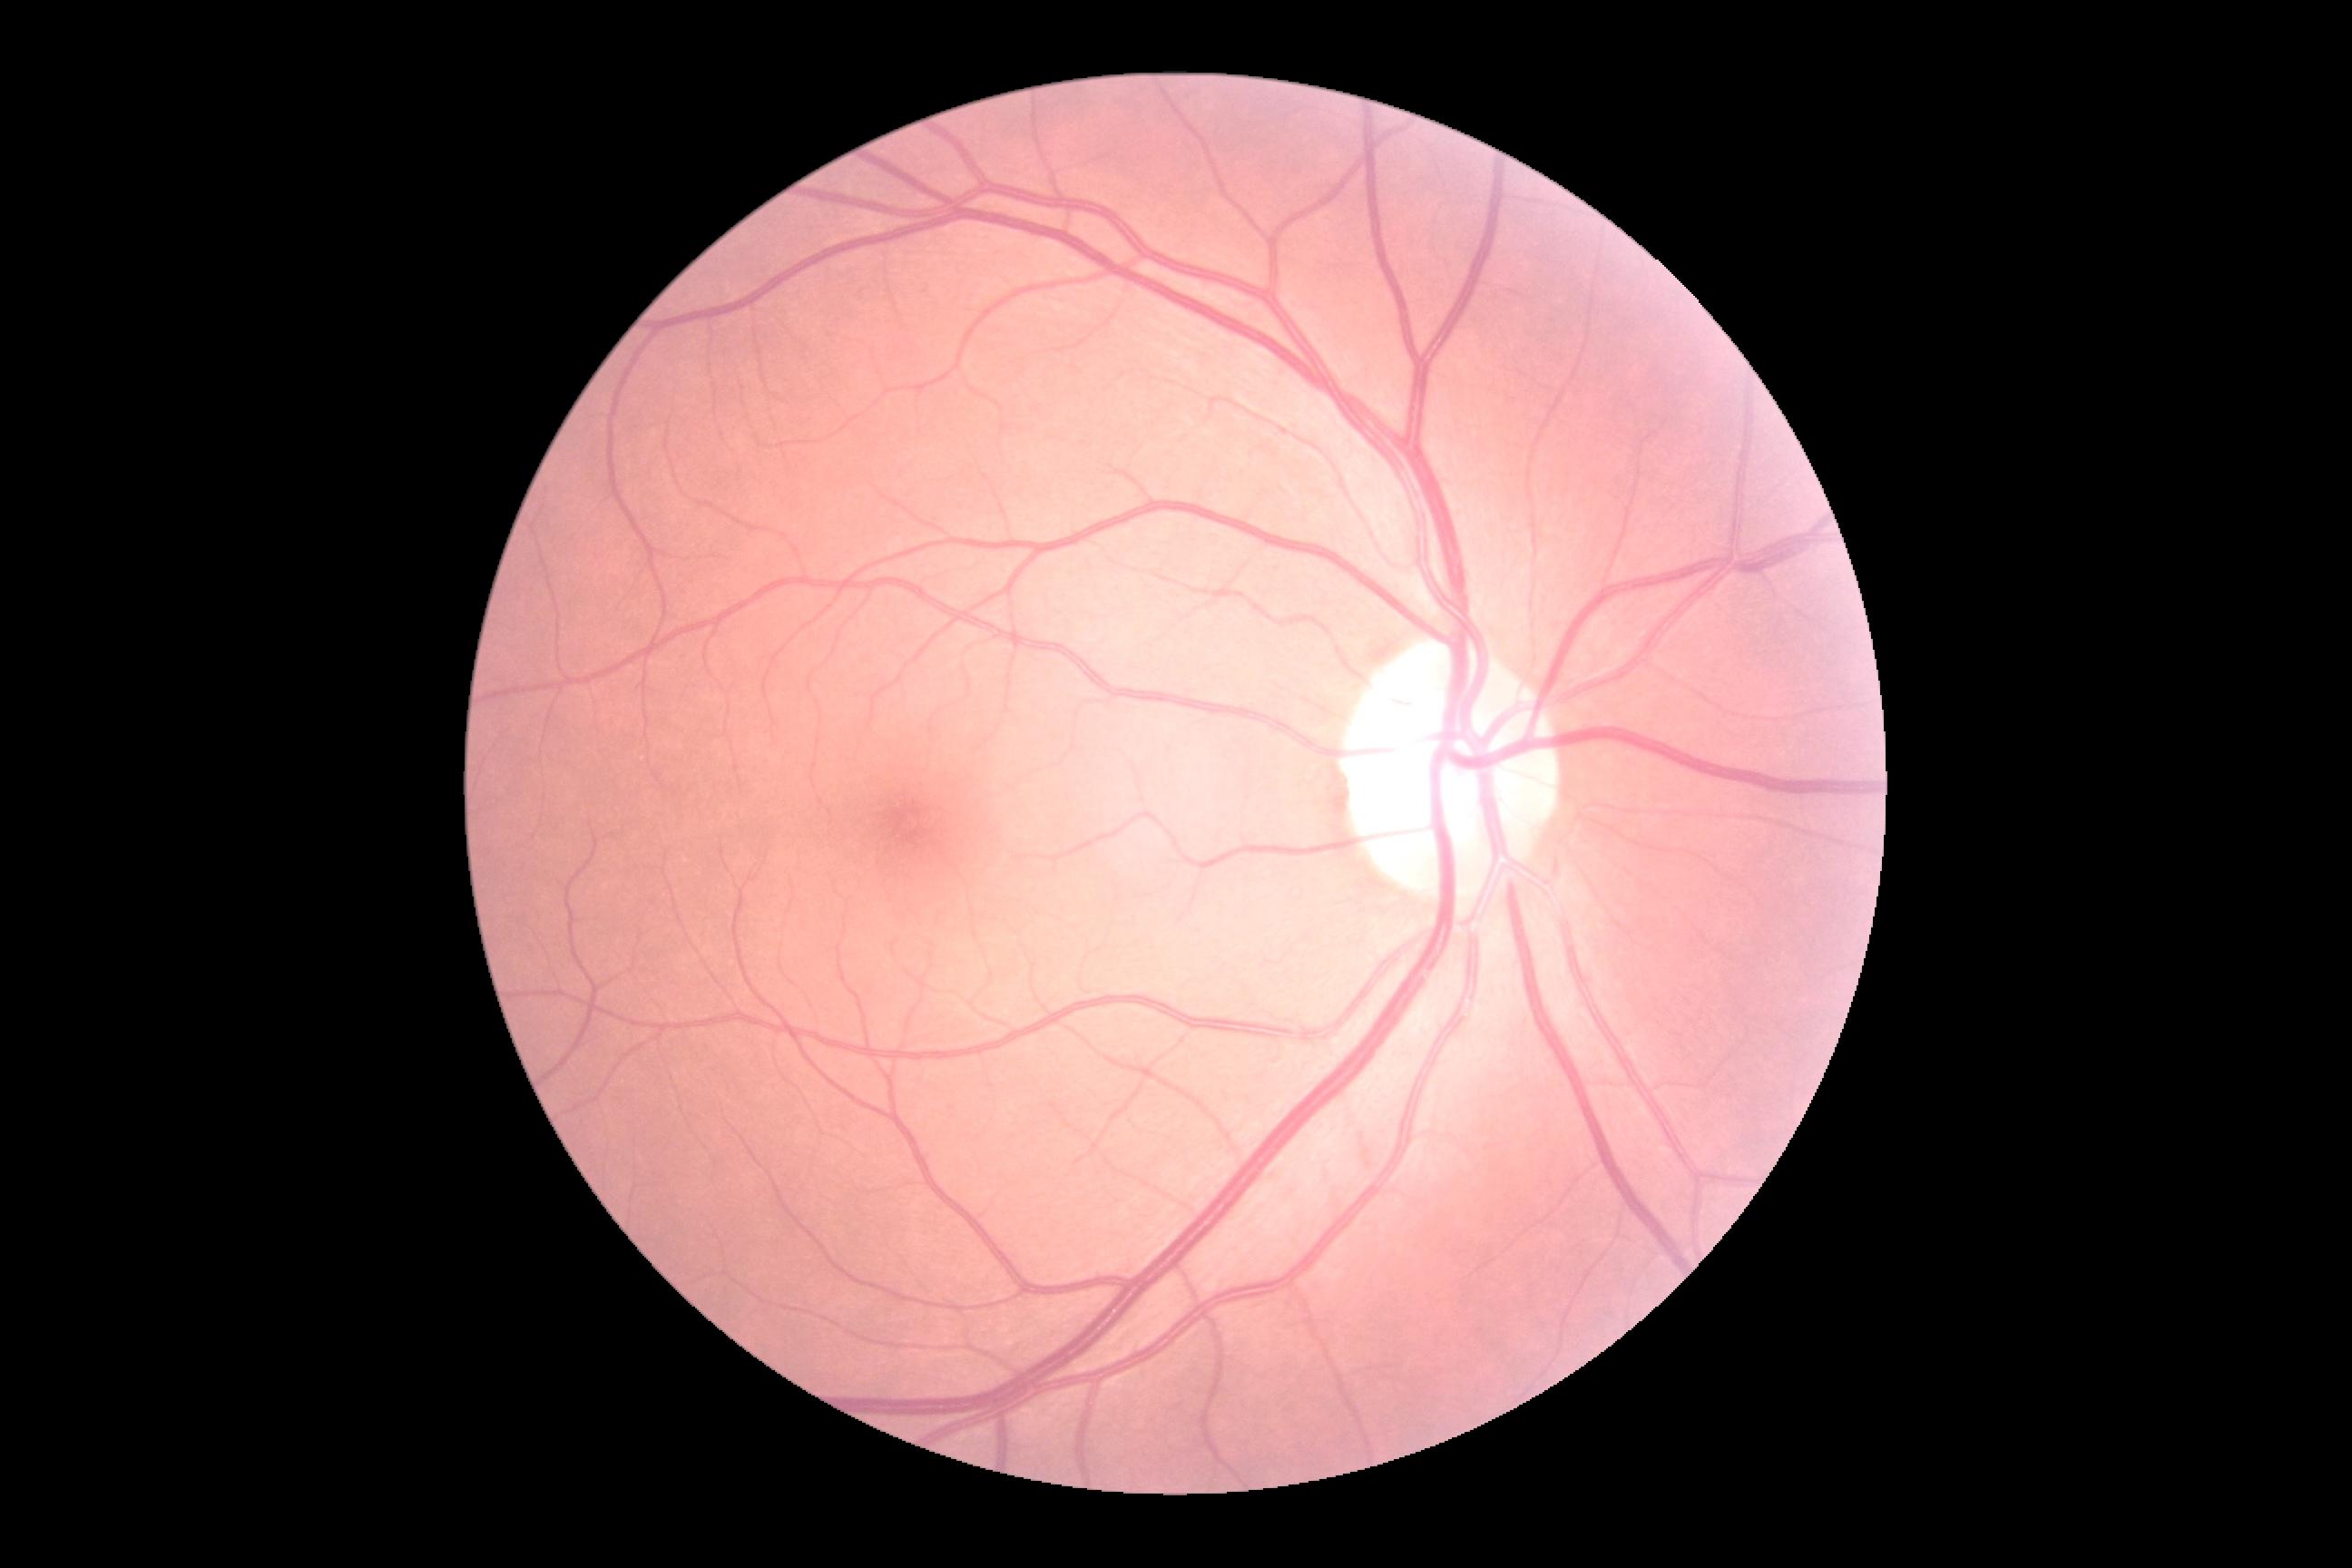

DR stage: grade 0 (no apparent retinopathy).